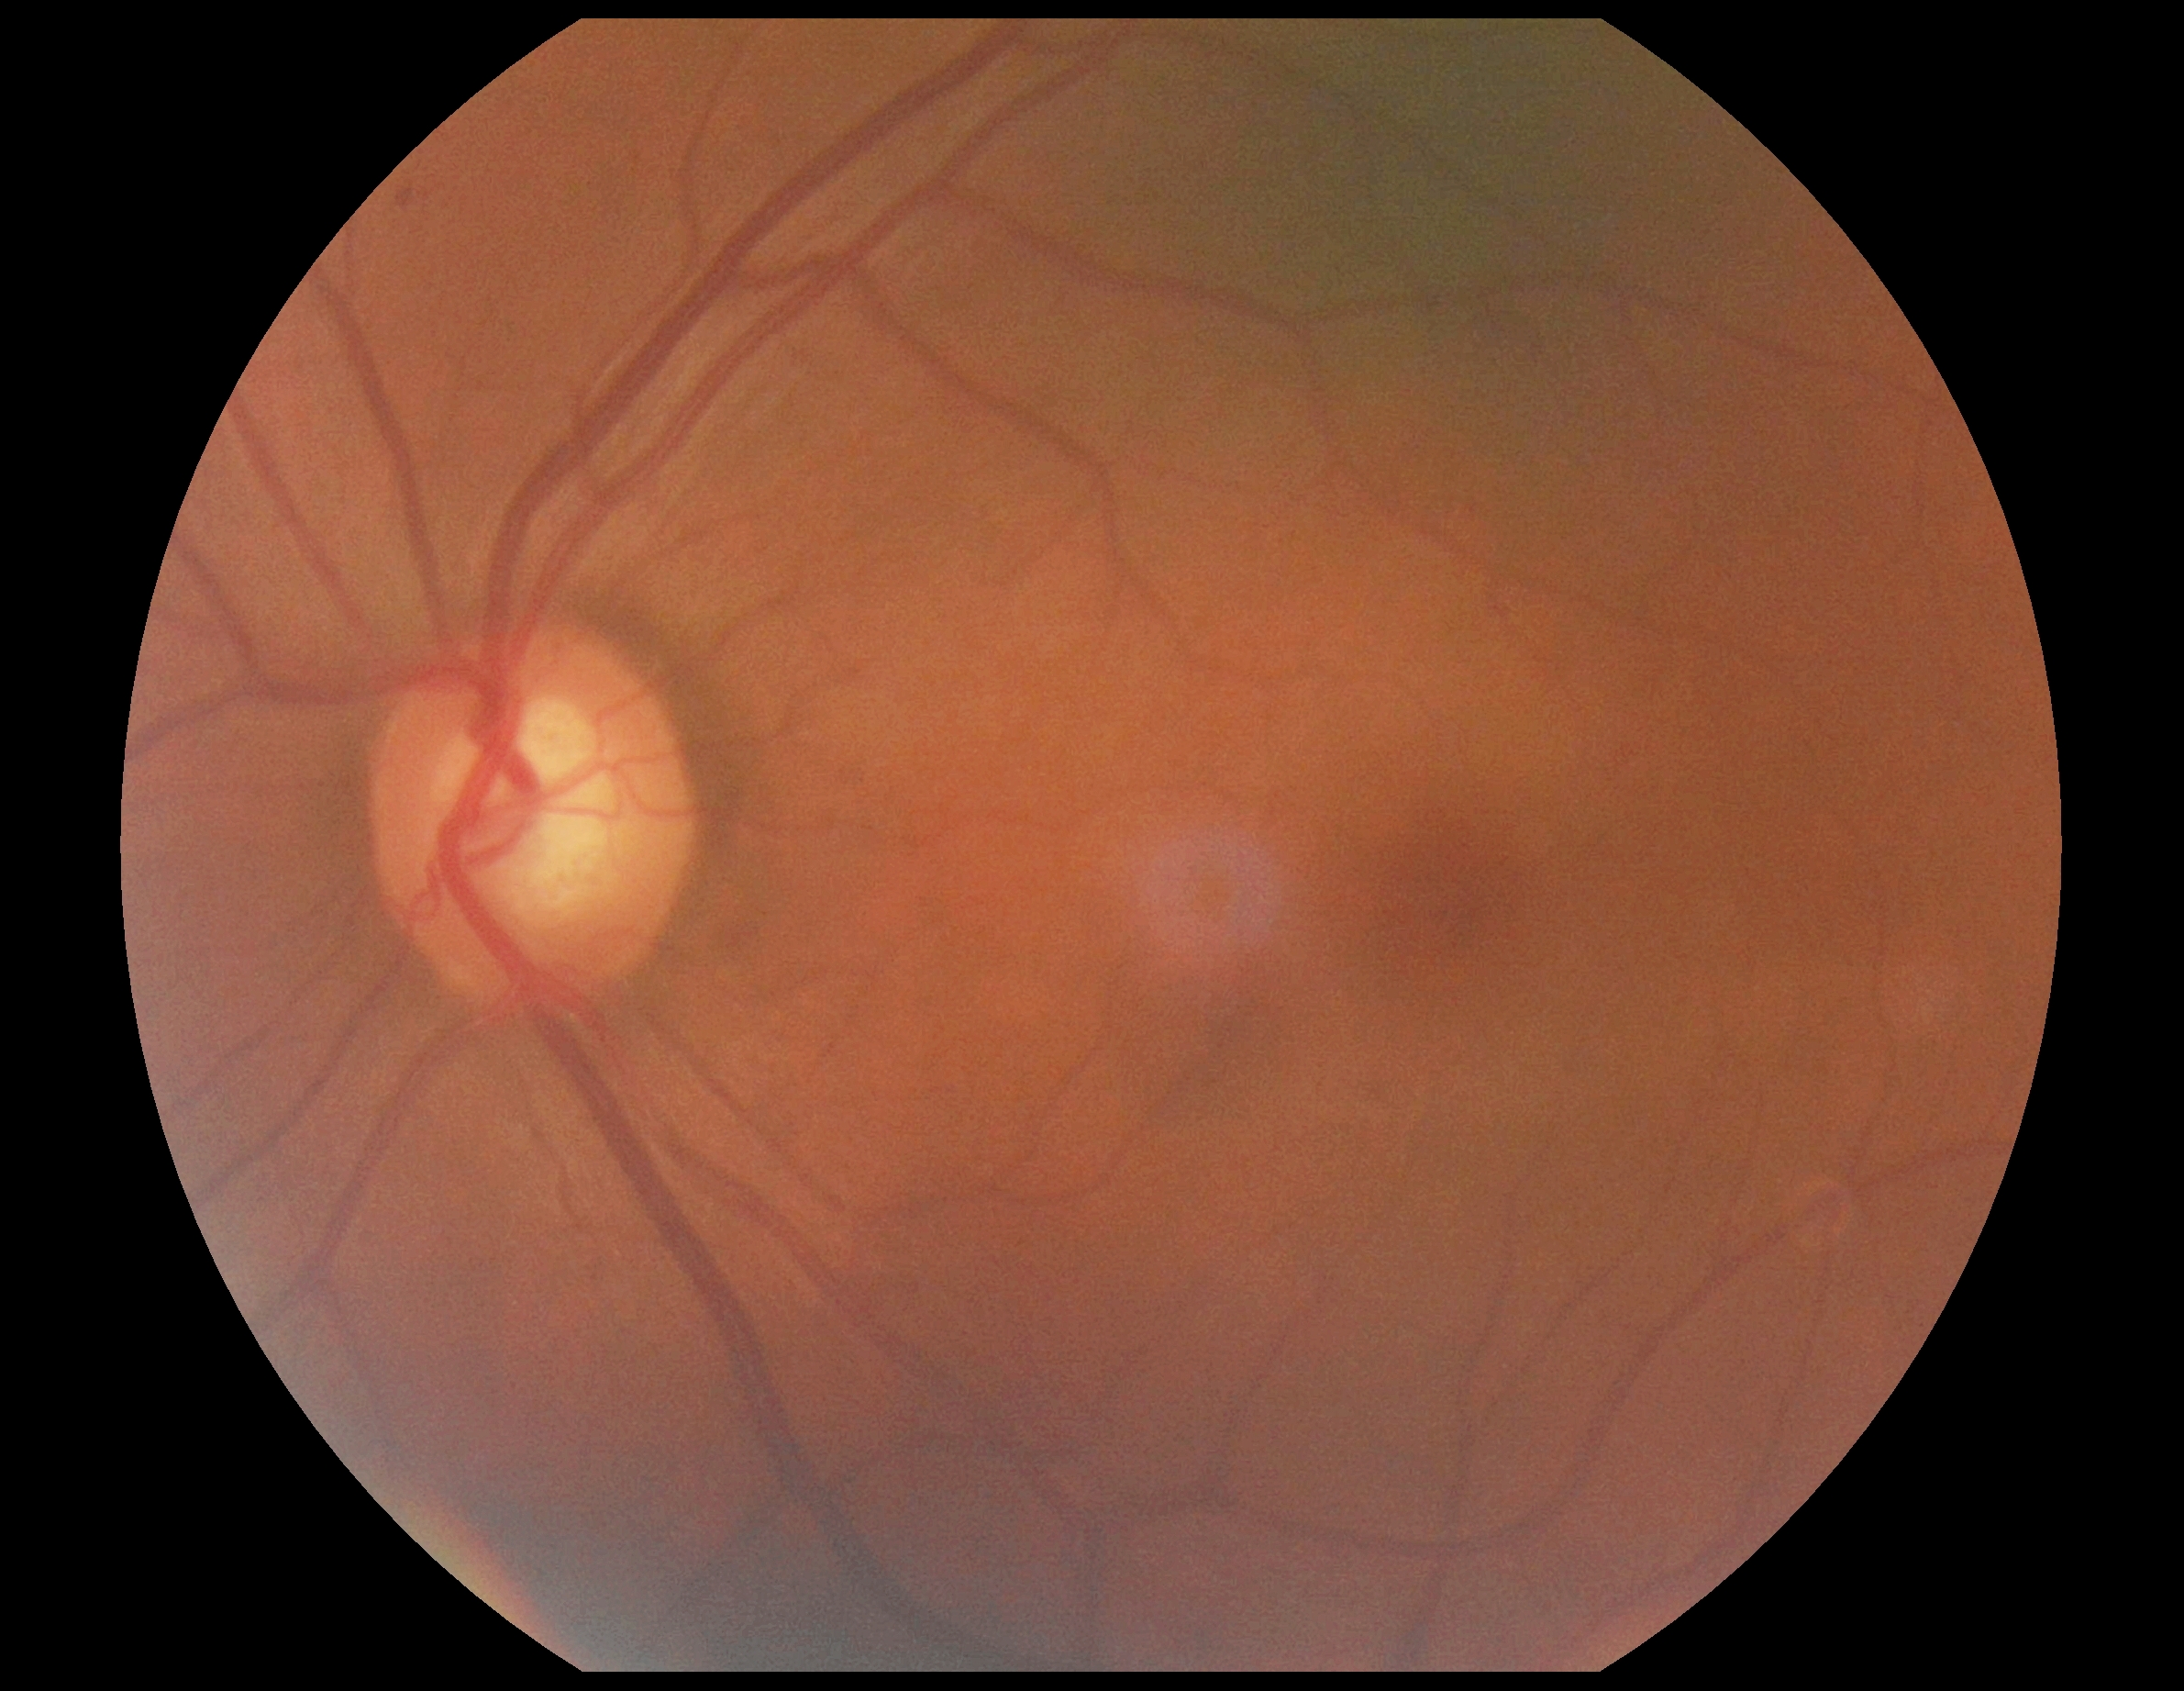 diabetic retinopathy (DR) = grade 0 (no apparent retinopathy), DR impression = negative for DR.